Diabetic retinopathy graded by the modified Davis classification, NIDEK AFC-230 fundus camera, 848x848, no pharmacologic dilation: 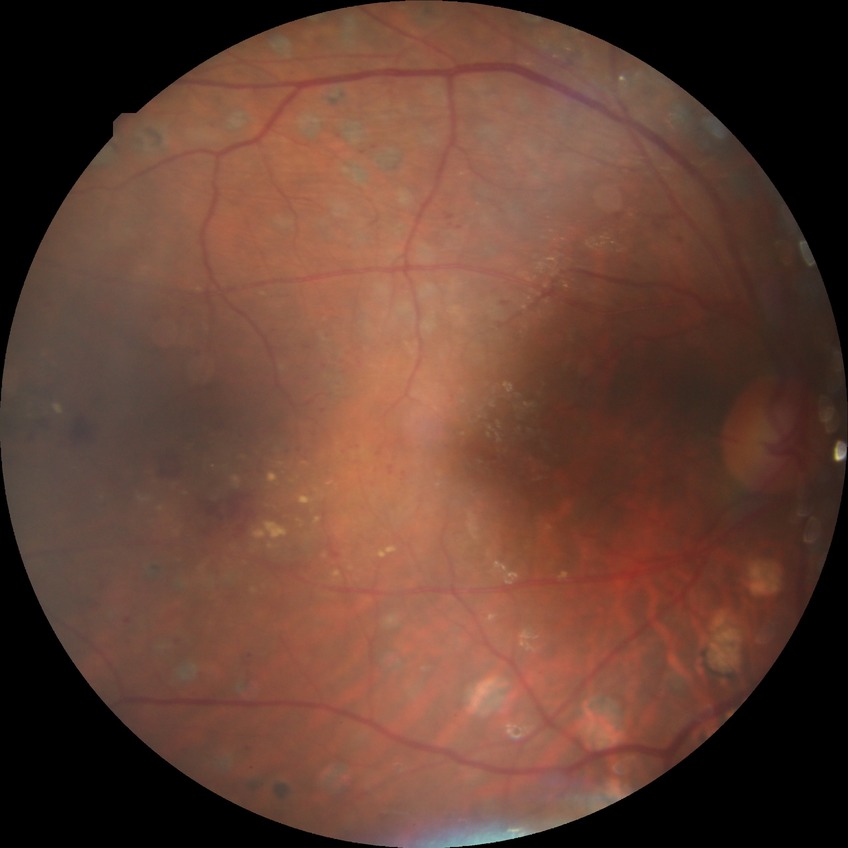 DR severity@PDR.